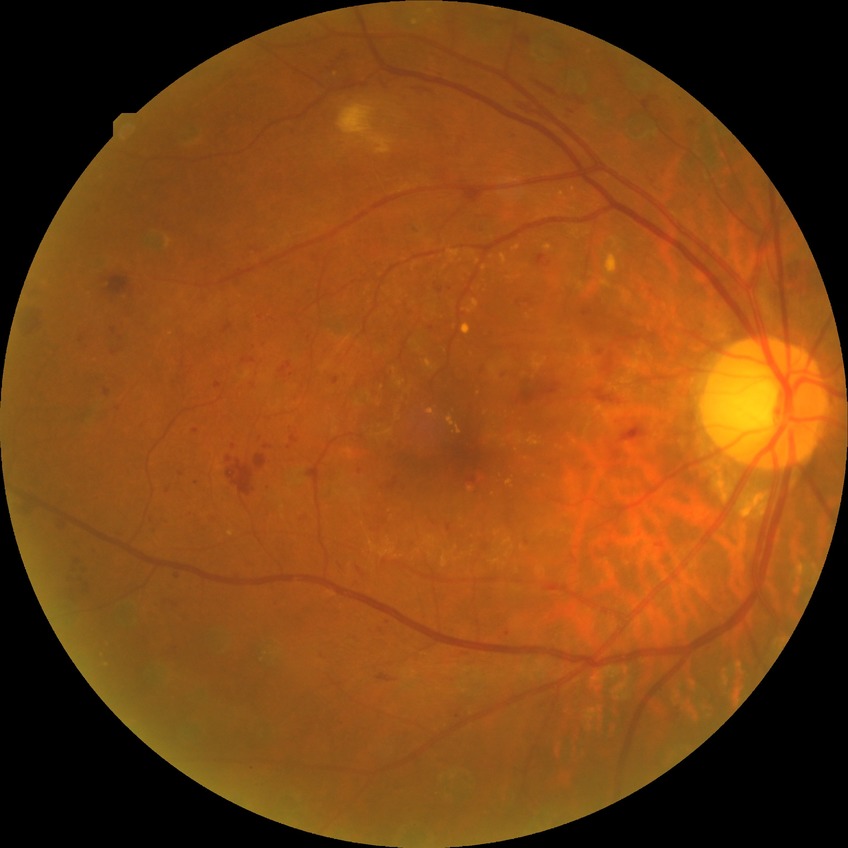 Diabetic retinopathy (DR) is proliferative diabetic retinopathy (PDR).